337x337px · disc-centered fundus crop
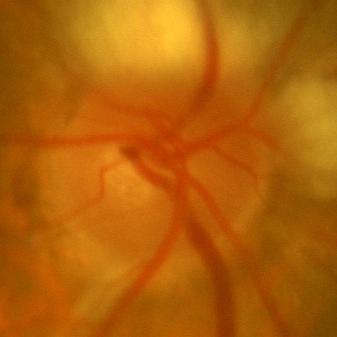

Q: Does this eye have glaucoma?
A: No glaucomatous findings.